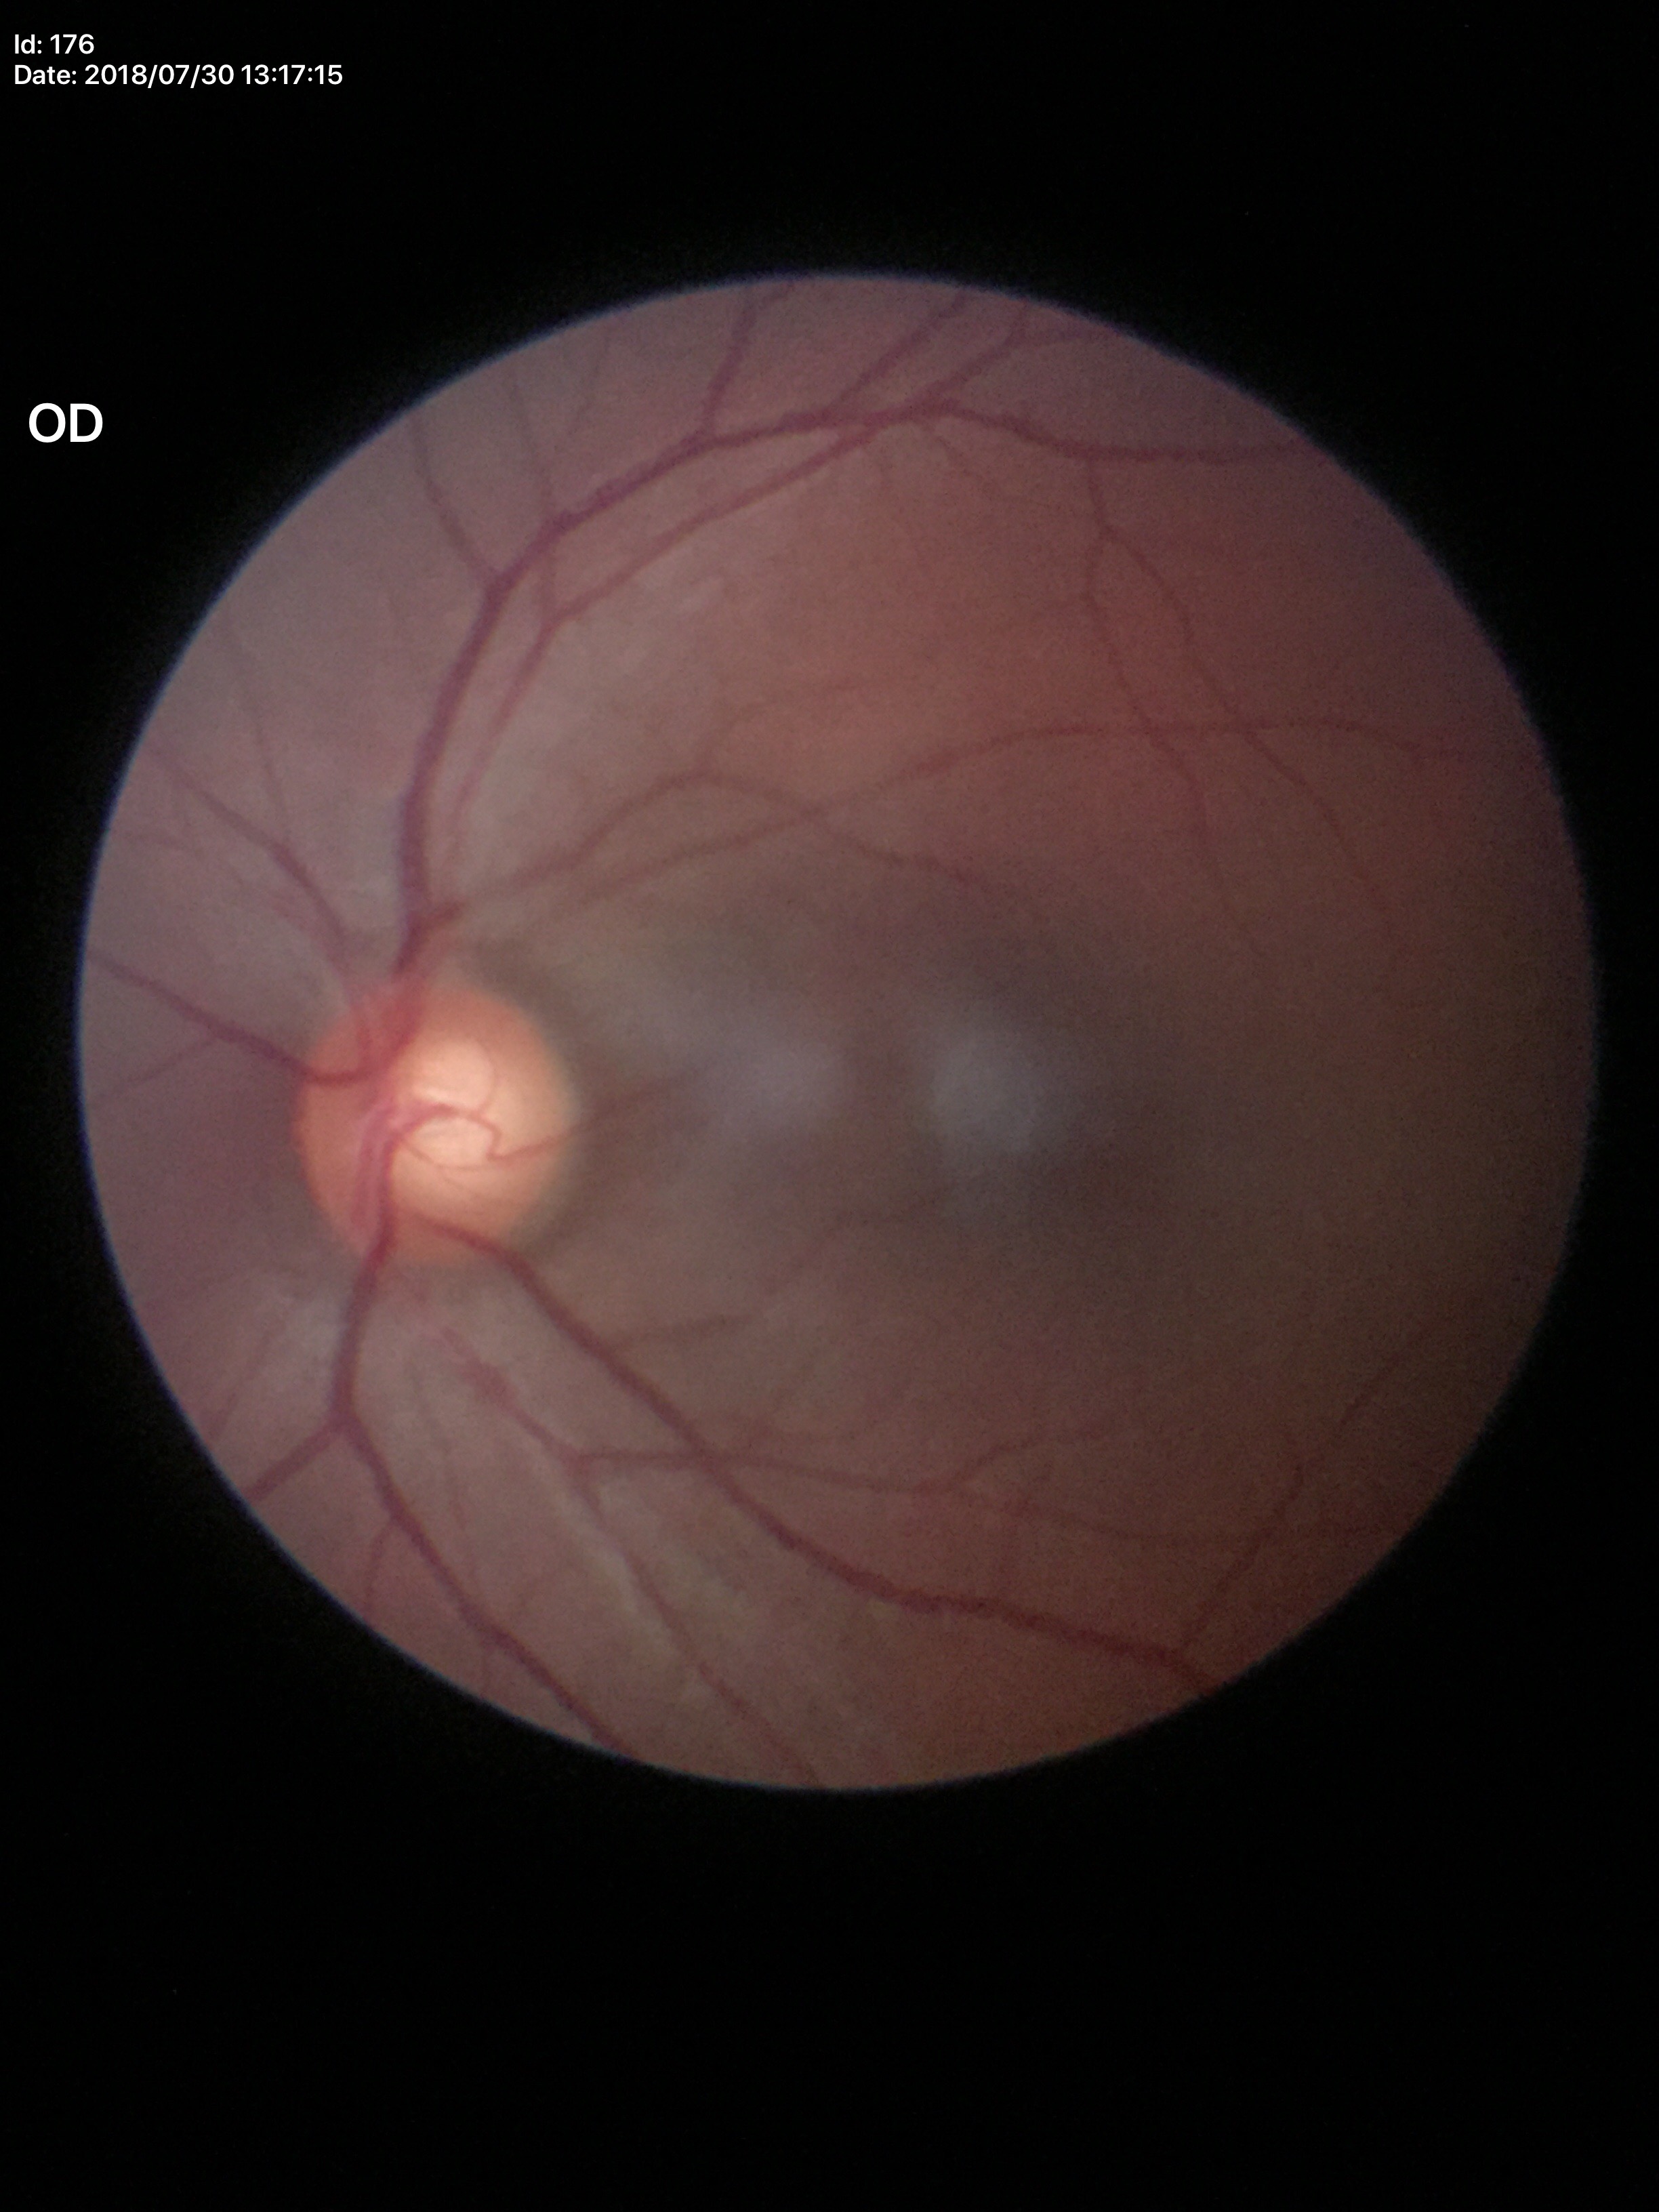
Glaucoma screening impression = suspect; VCDR = 0.62.